Wide-field fundus photograph of an infant · 1440x1080:
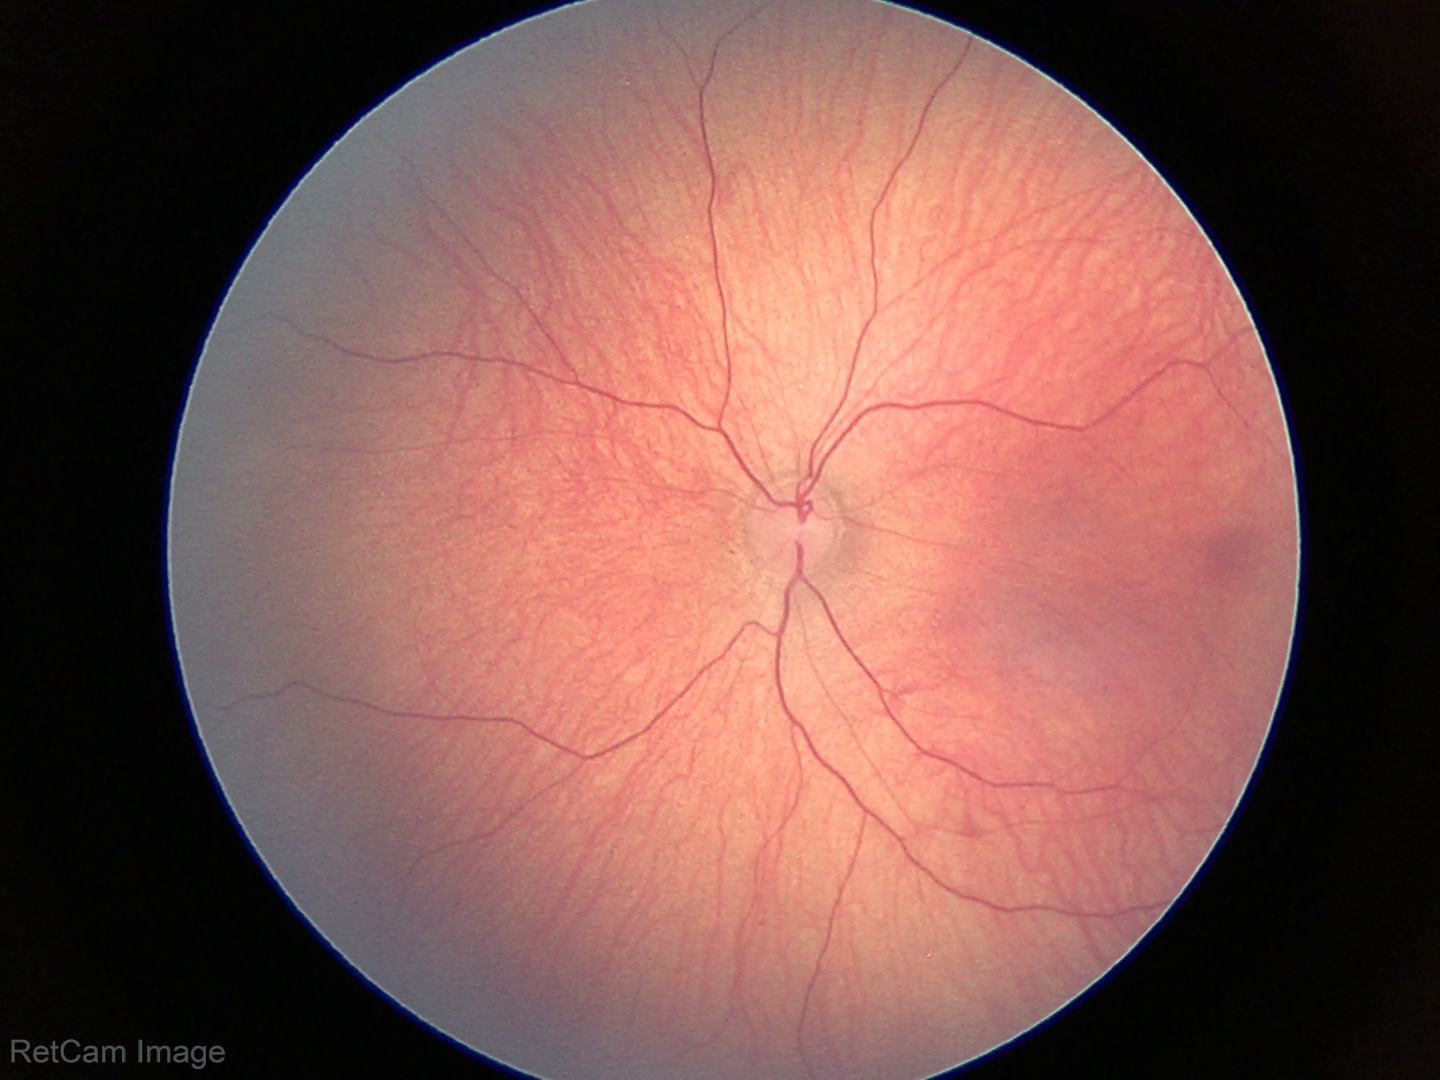 Impression = normal retinal appearance.